Modified Davis classification
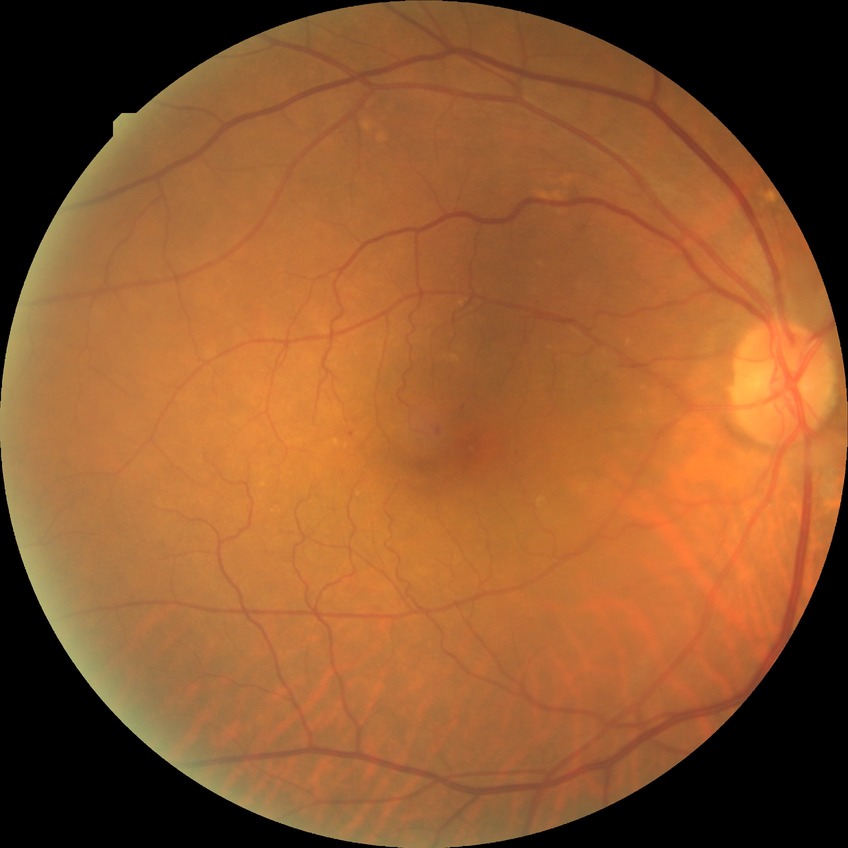

diabetic retinopathy stage = simple diabetic retinopathy.